45° FOV.
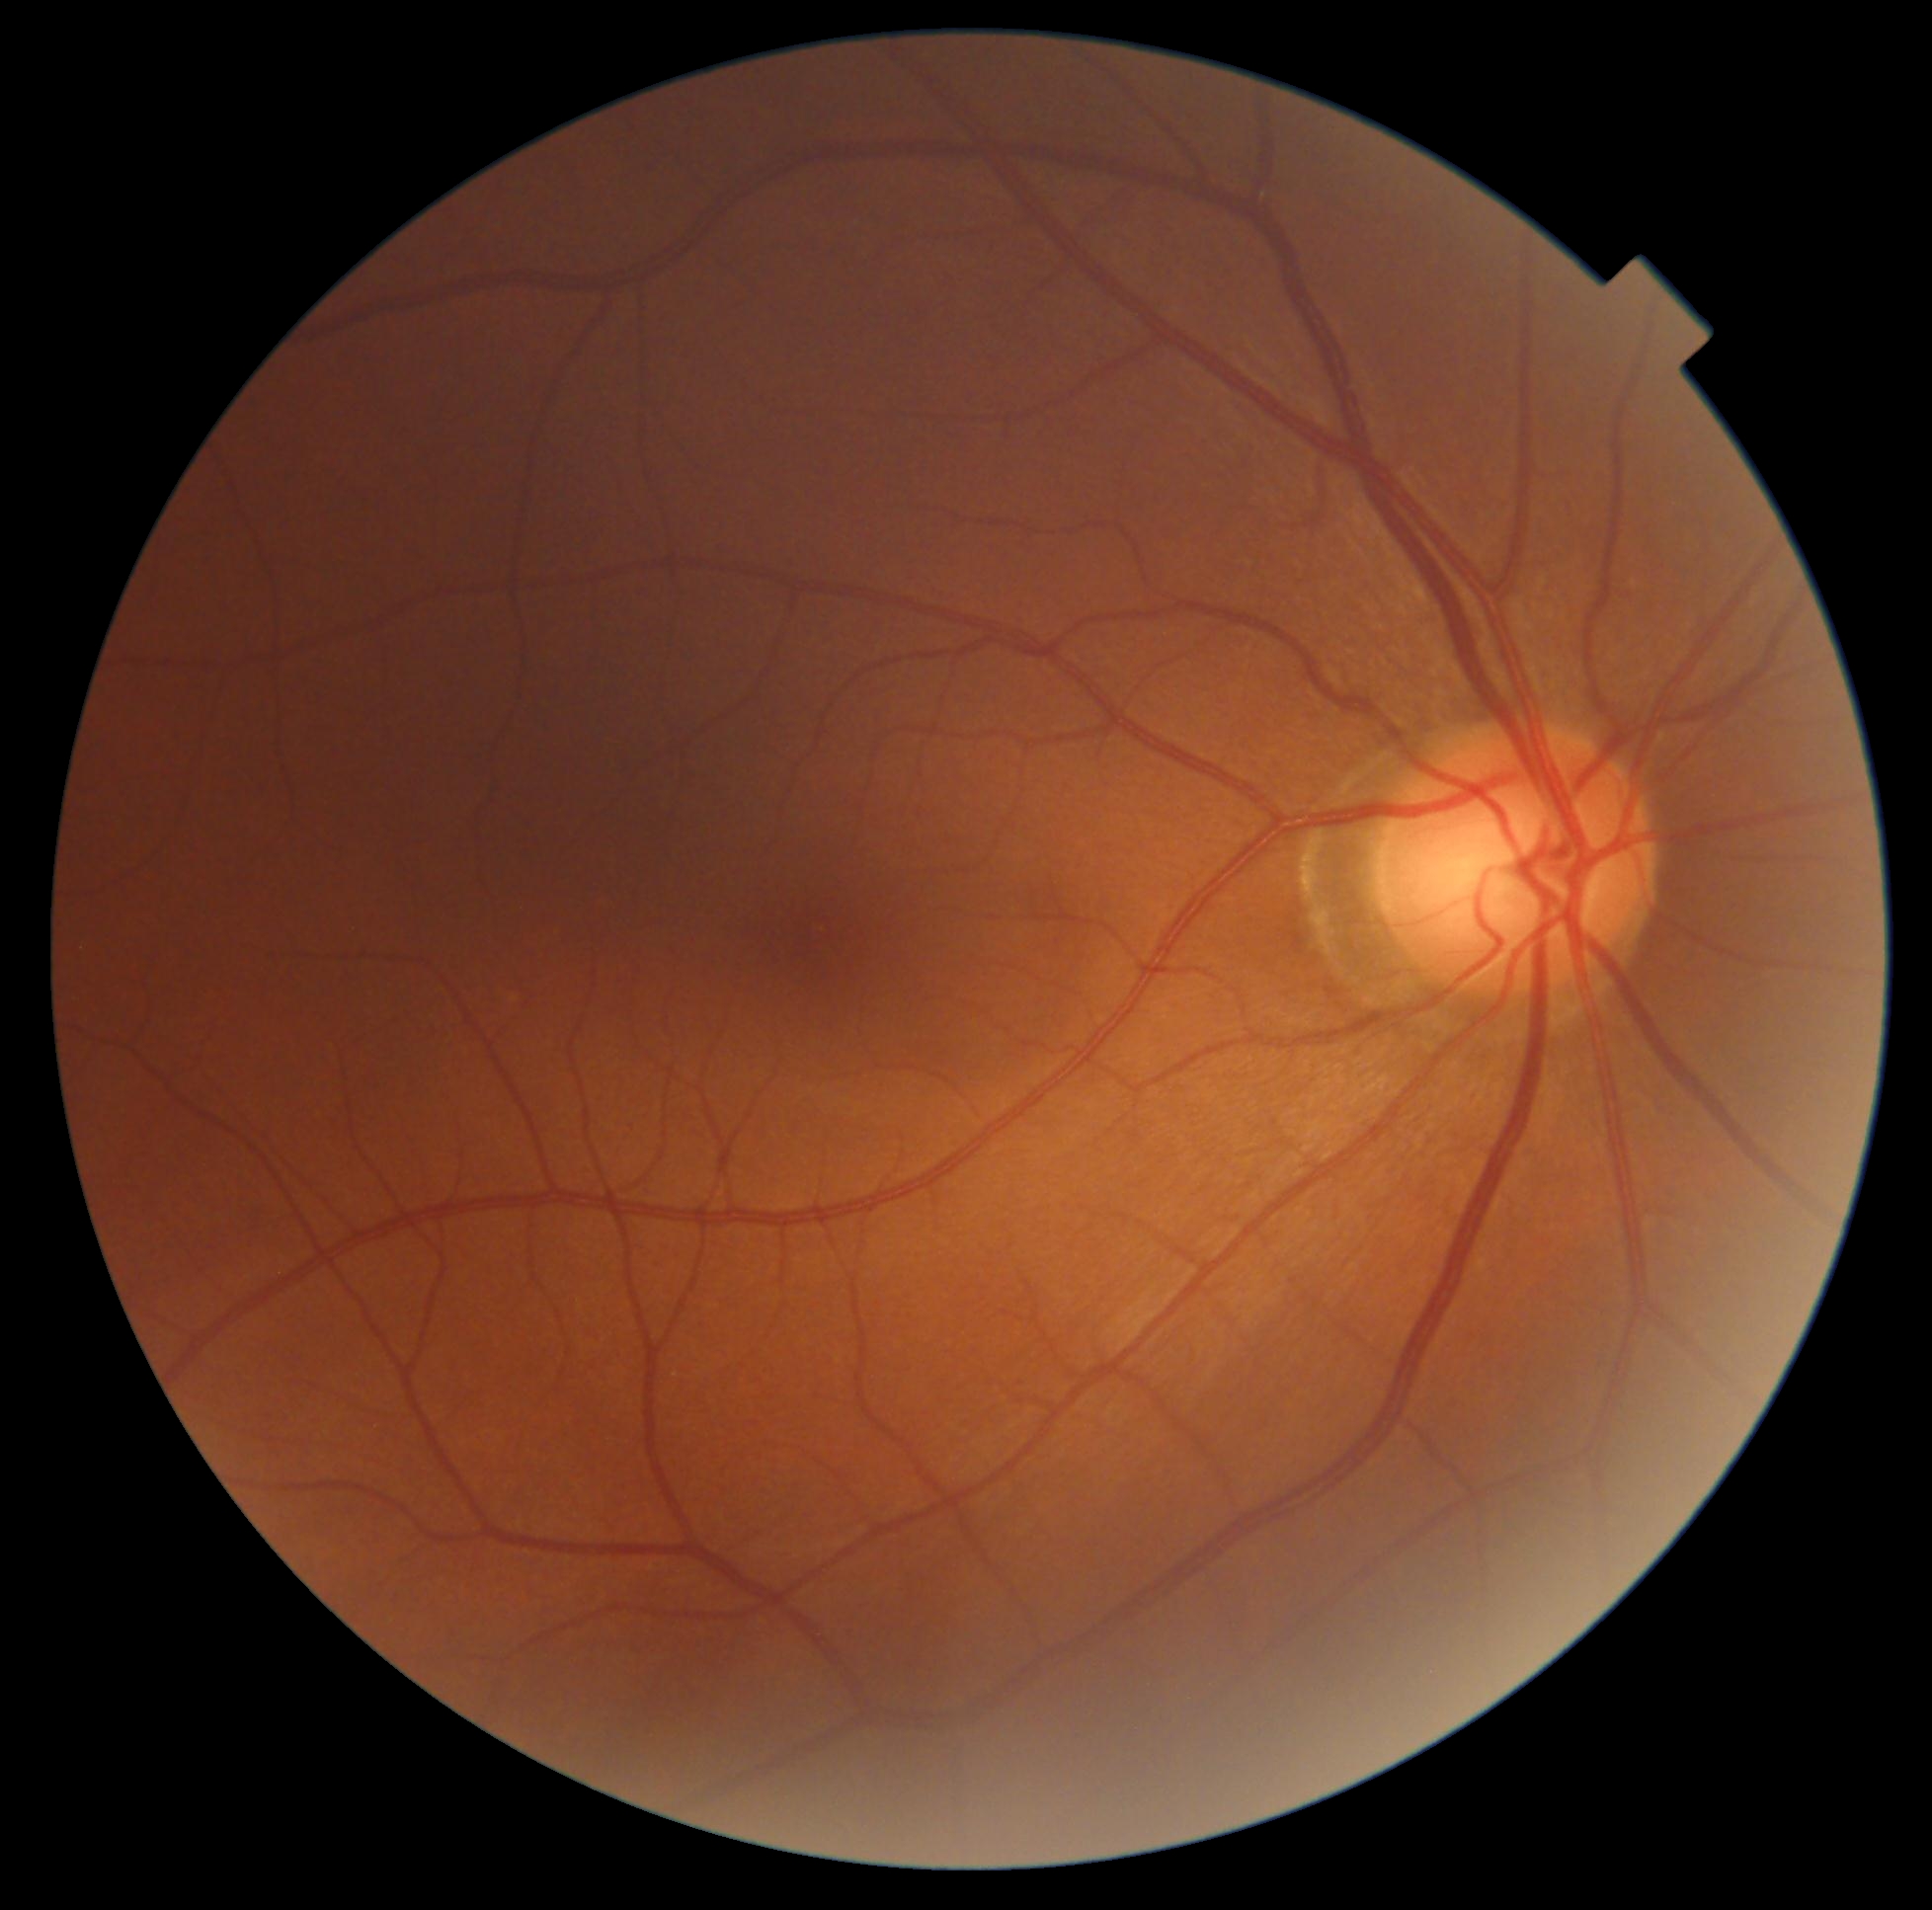 diabetic retinopathy = no apparent diabetic retinopathy (grade 0) — no visible signs of diabetic retinopathy